No pharmacologic dilation; image size 848x848; retinal fundus photograph; diabetic retinopathy graded by the modified Davis classification.
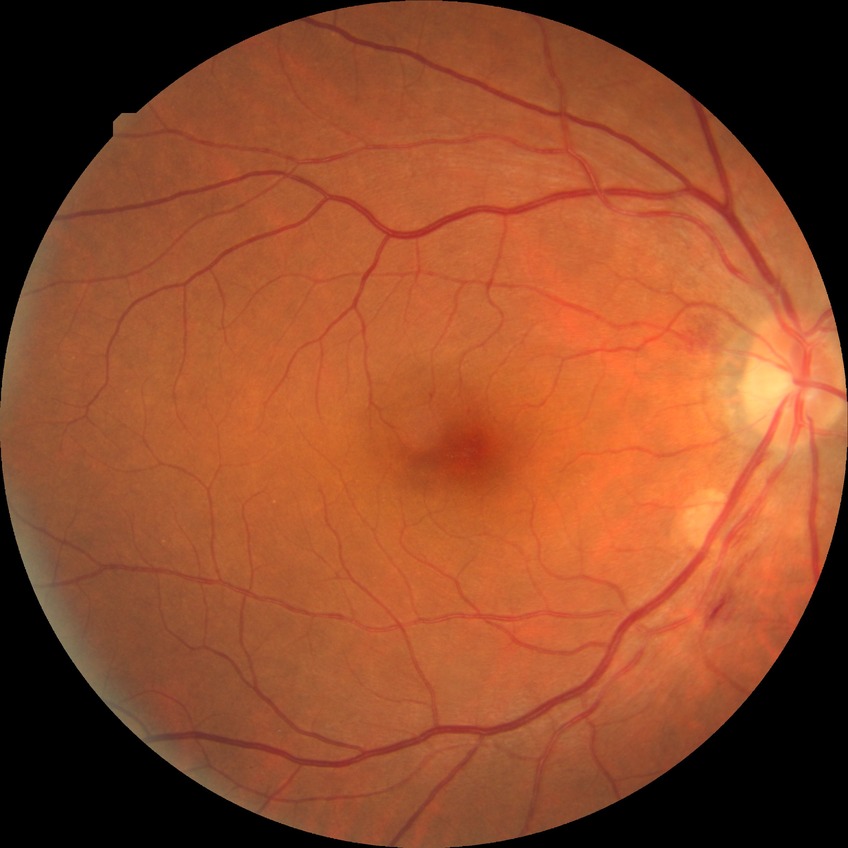 Modified Davis classification: simple diabetic retinopathy.